Fundus photo — 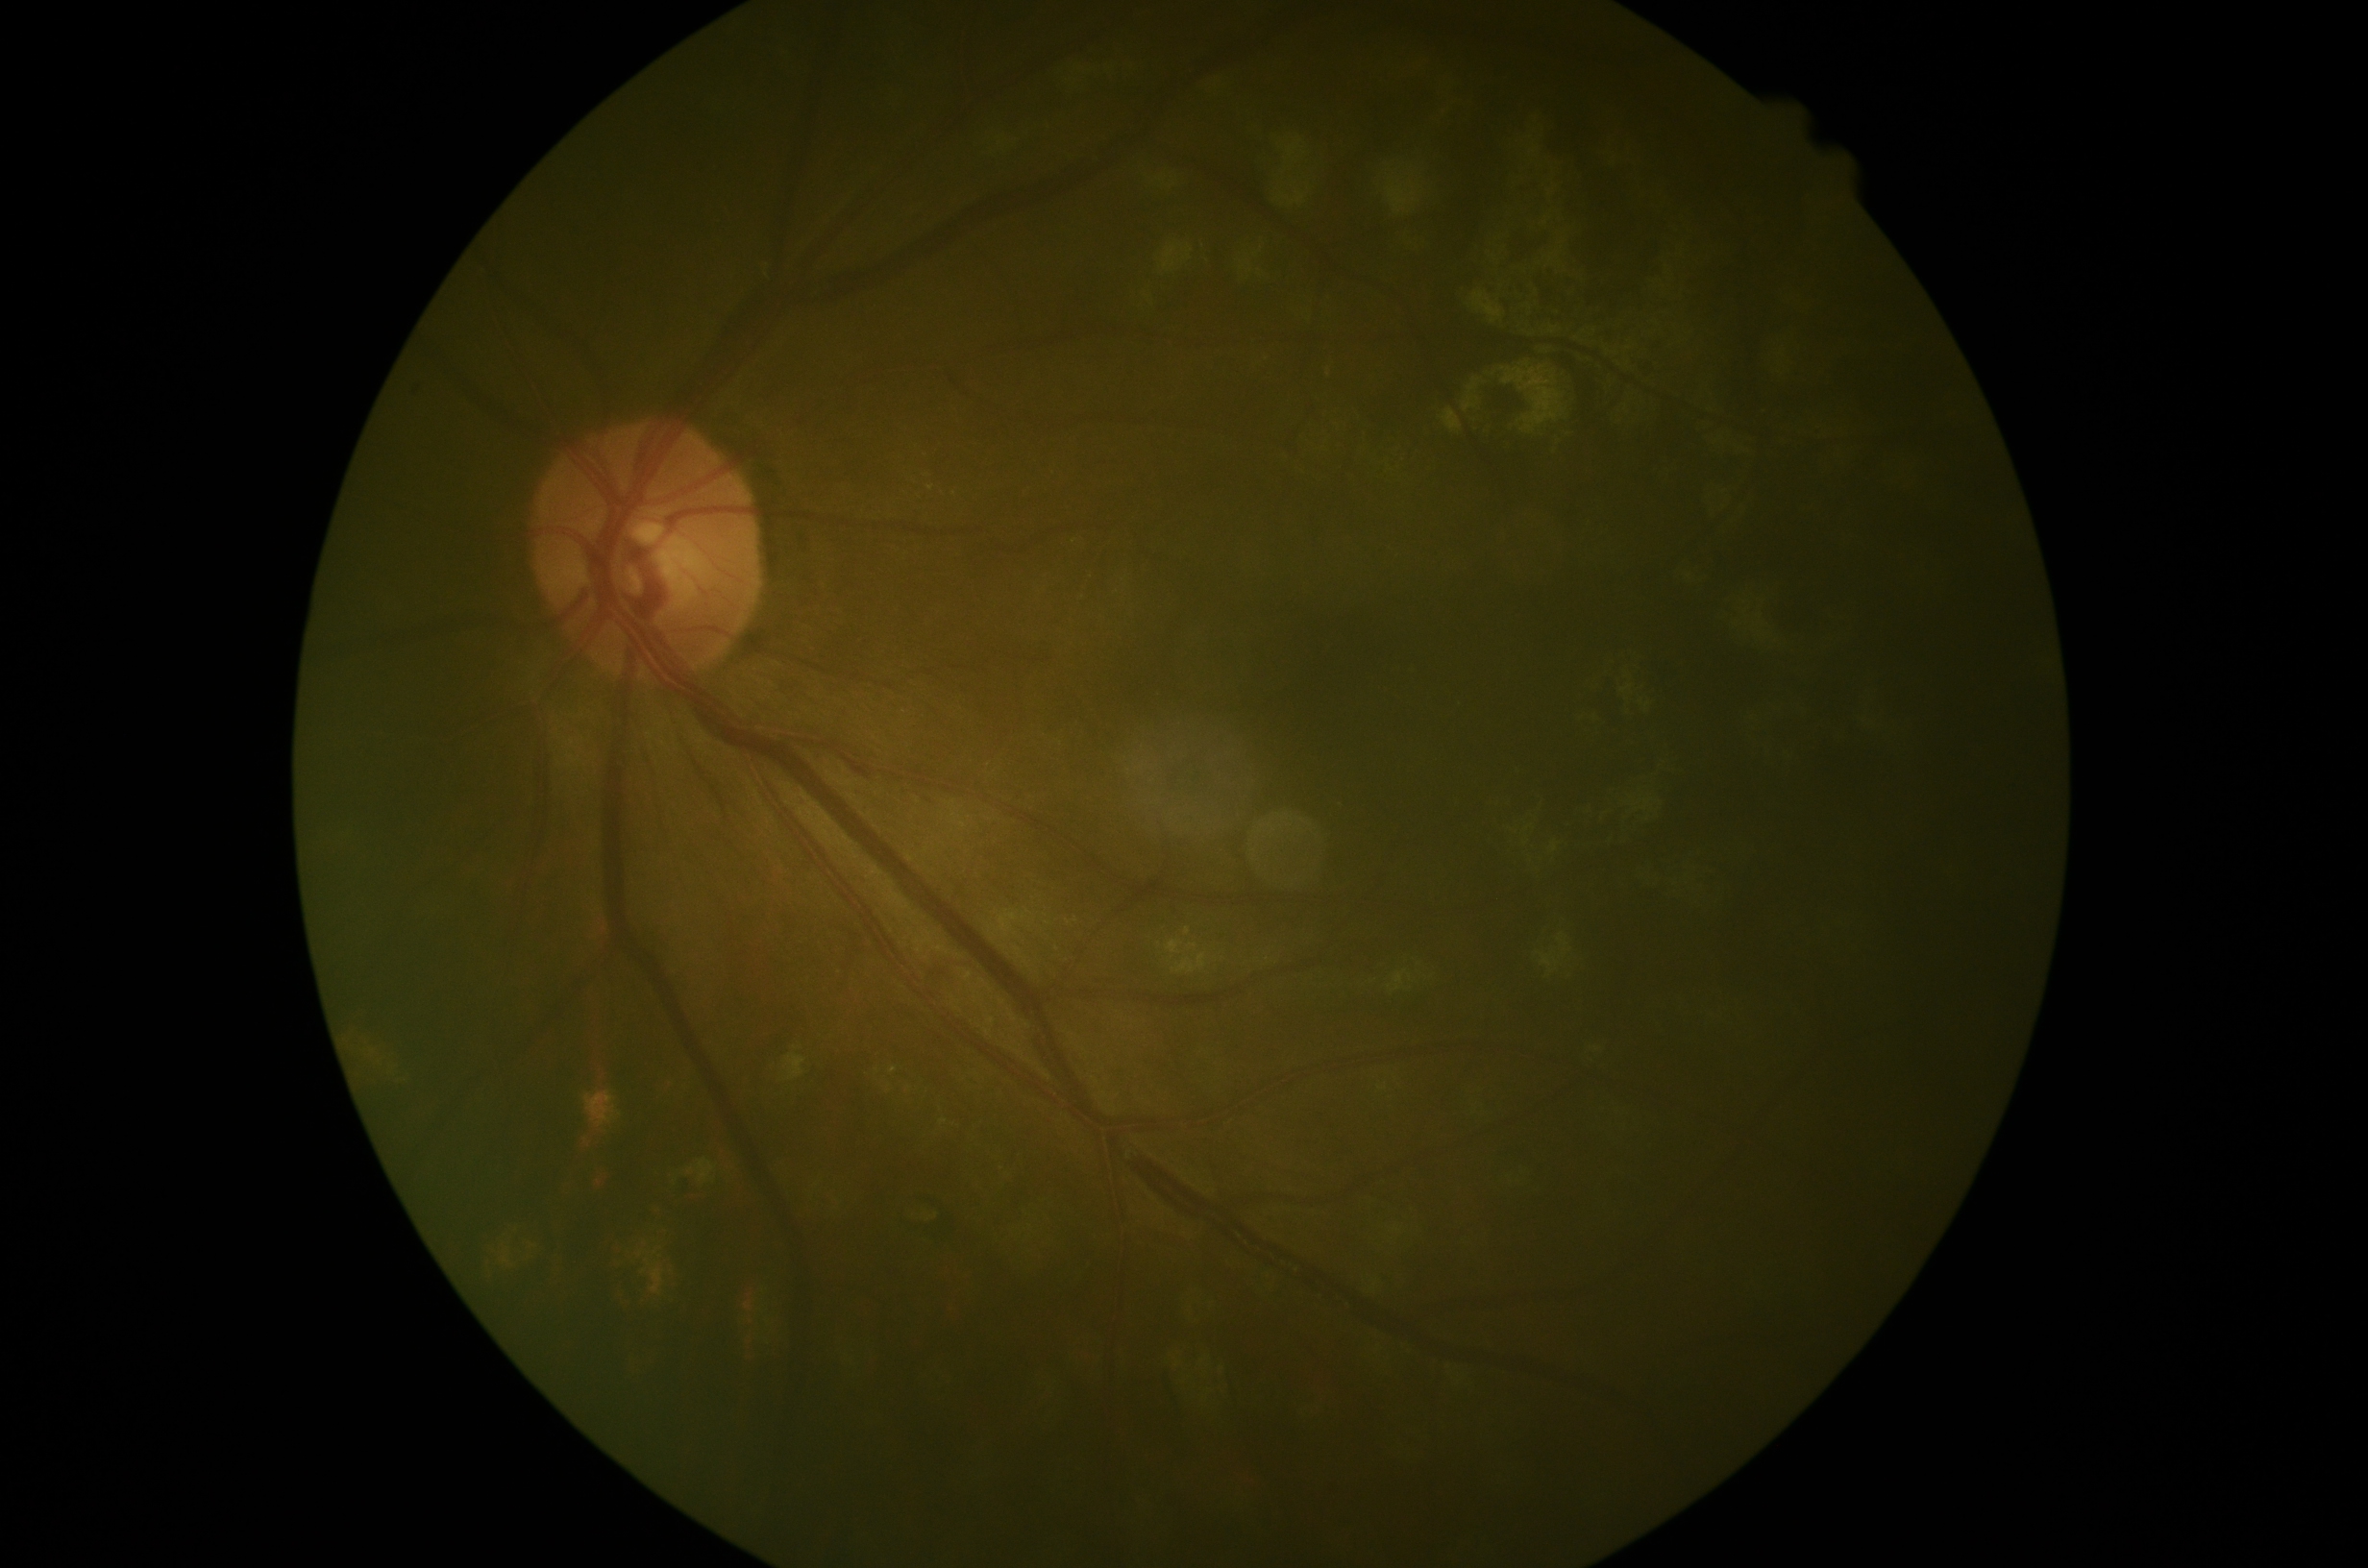

diabetic retinopathy (DR) = 2/4.